2361x1568px. Retinal fundus photograph. 50-degree field of view — 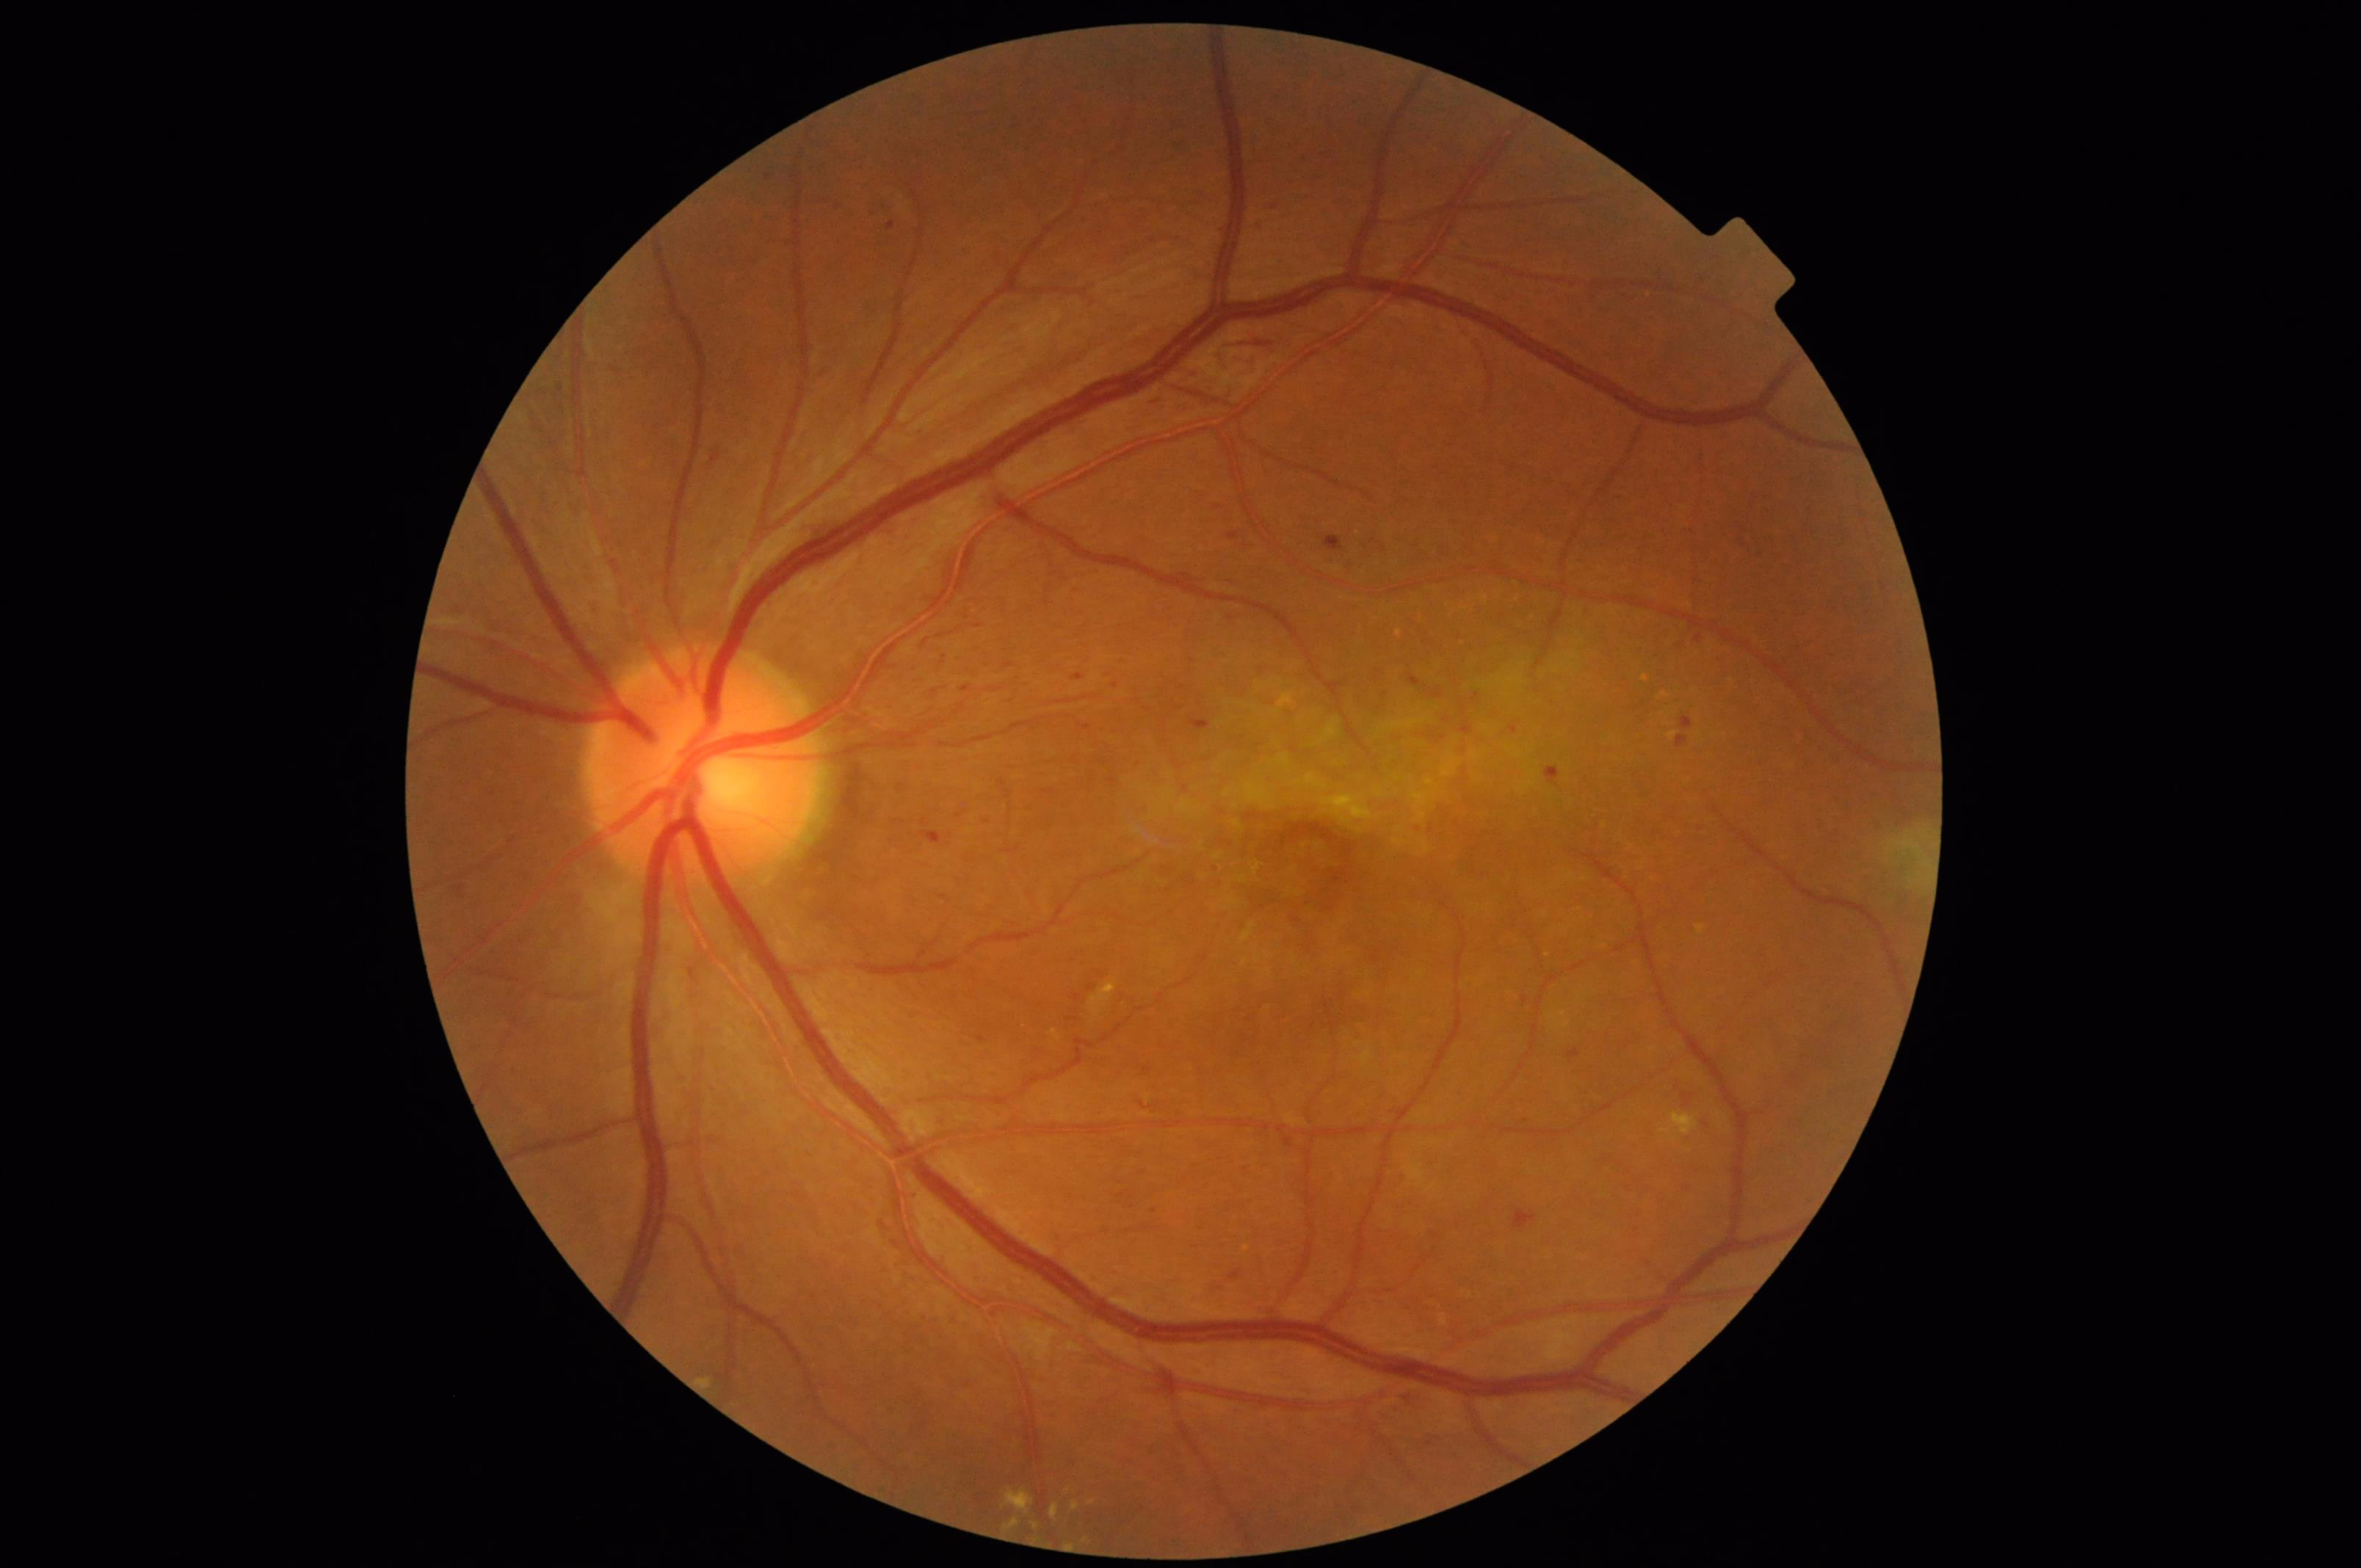

Image quality:
- illumination/color: satisfactory
- contrast: adequate
- overall: satisfactory
- sharpness: clear